Retinal fundus photograph.
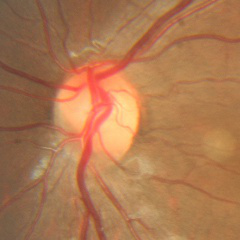
Showing no evidence of glaucoma.